45 degree fundus photograph; no pharmacologic dilation — 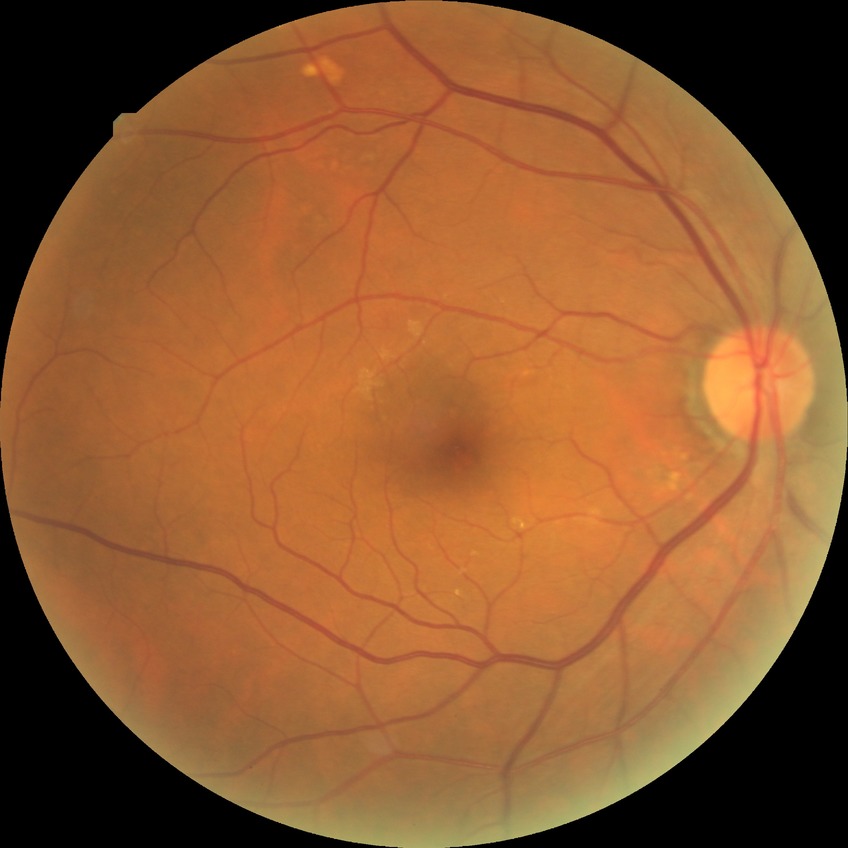 Diabetic retinopathy (DR) is no diabetic retinopathy (NDR).